Nonmydriatic fundus photograph · retinal fundus photograph · 45° field of view · 848x848
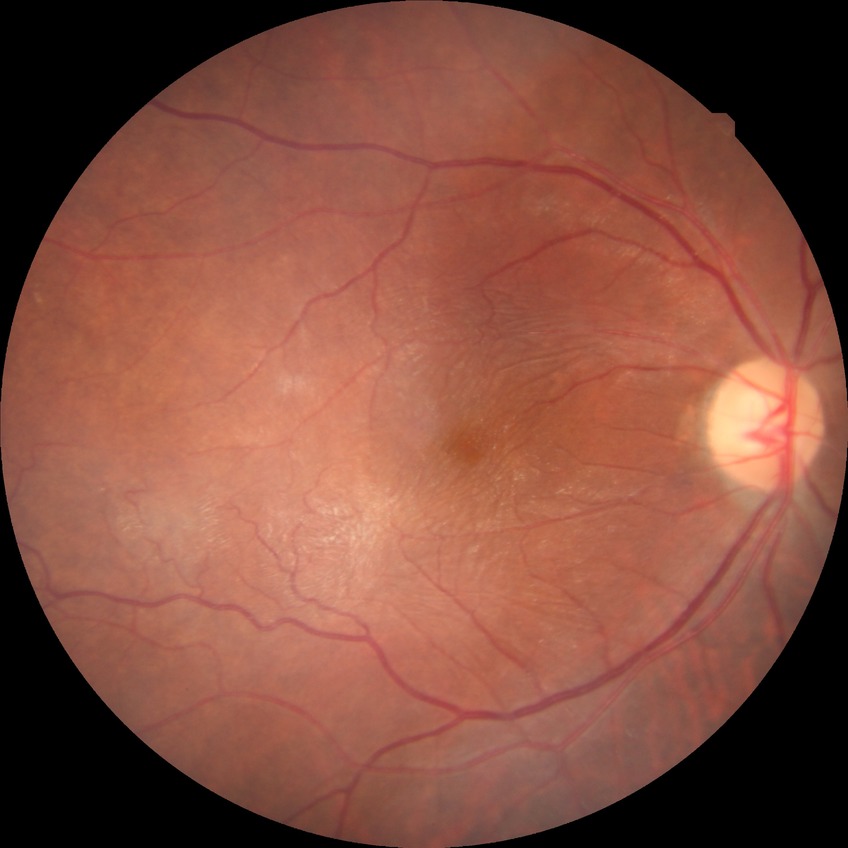
diabetic retinopathy (DR): no diabetic retinopathy (NDR).